2352x1568. Color fundus image:
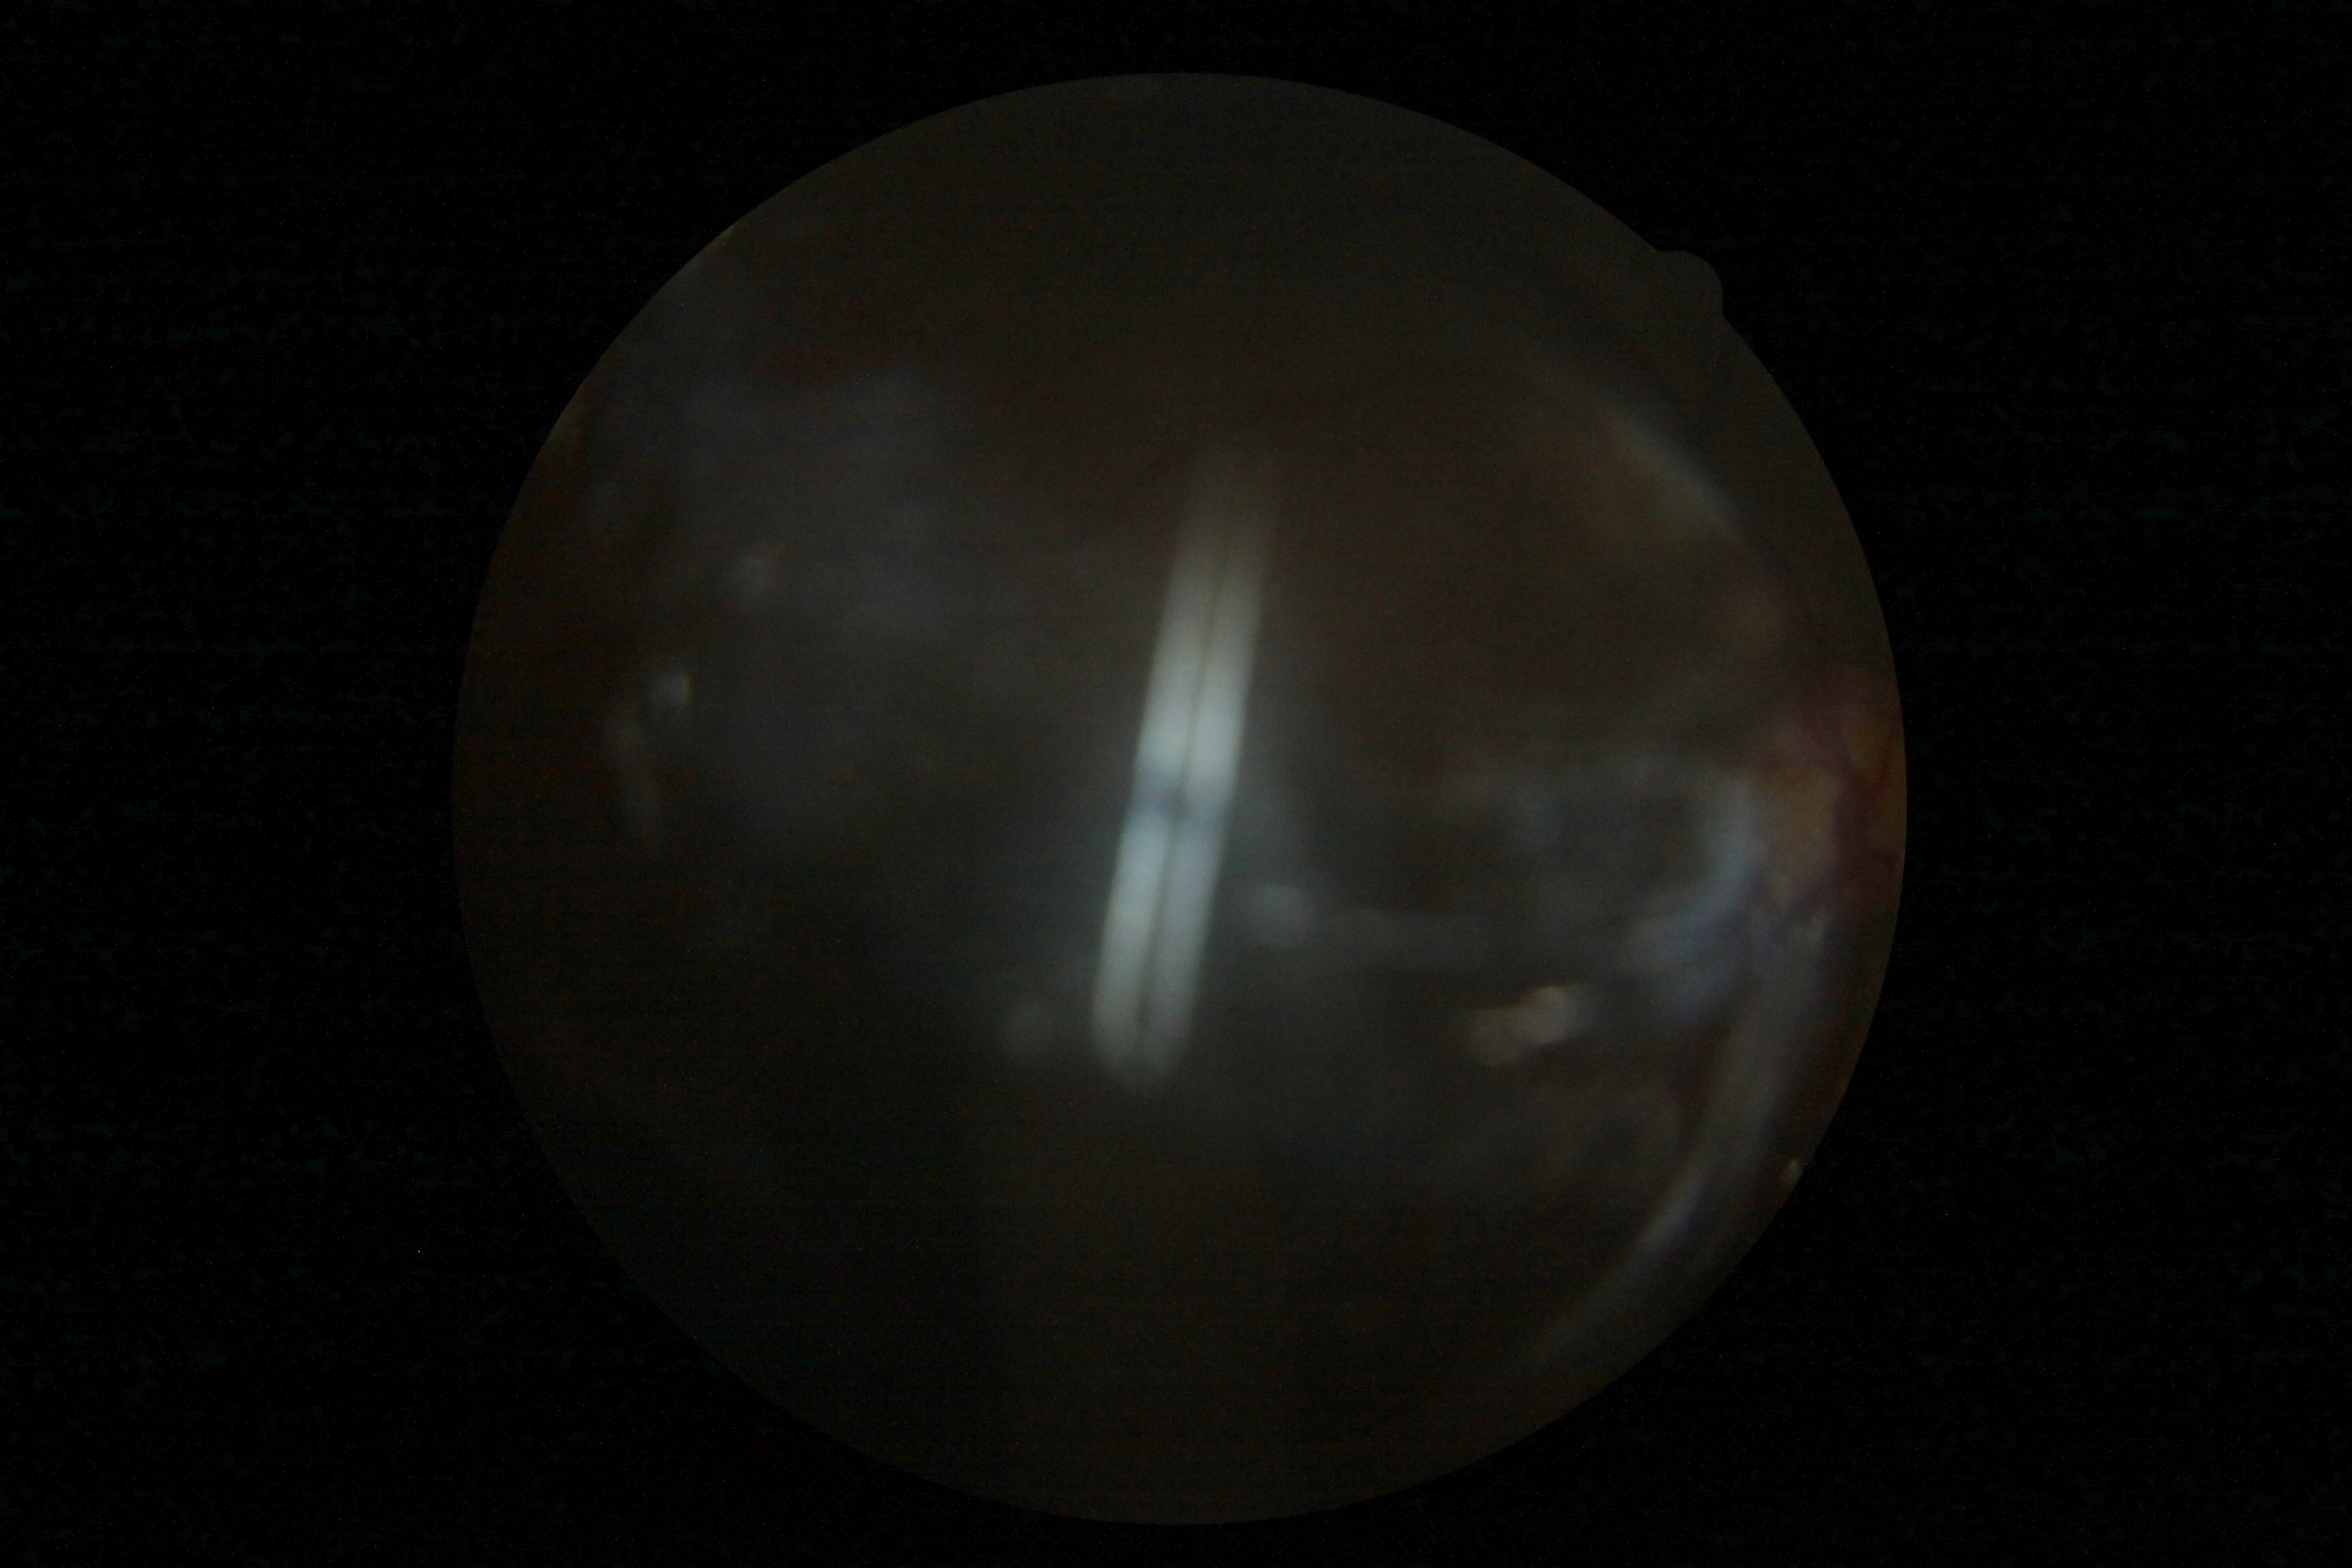

- image quality: insufficient for DR assessment
- DR stage: ungradable